FOV: 45 degrees. NIDEK AFC-230
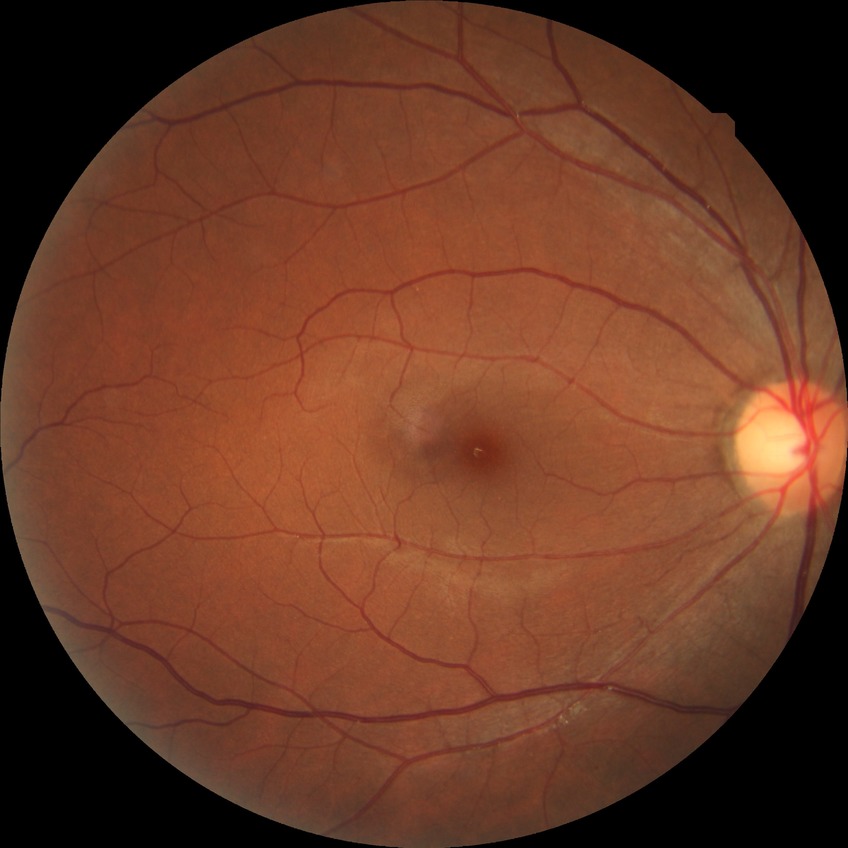

Diabetic retinopathy (DR) is no diabetic retinopathy (NDR).